Wide-field contact fundus photograph of an infant
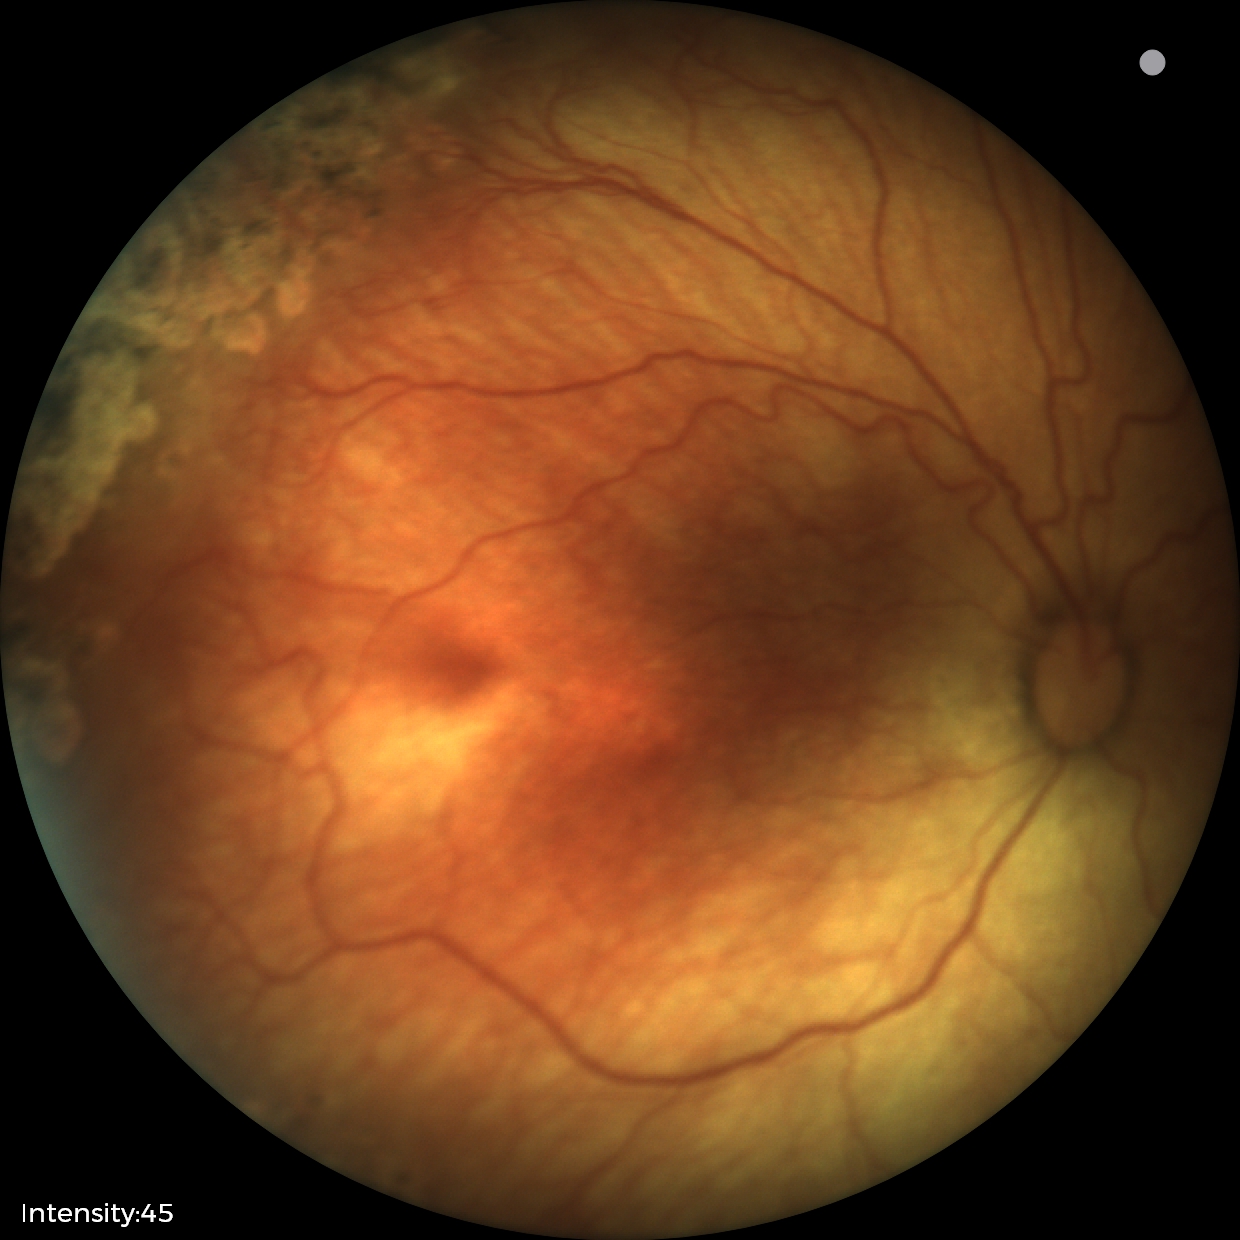 Plus disease = absent
impression = status post ROP